848 by 848 pixels; color fundus image; modified Davis classification; camera: NIDEK AFC-230.
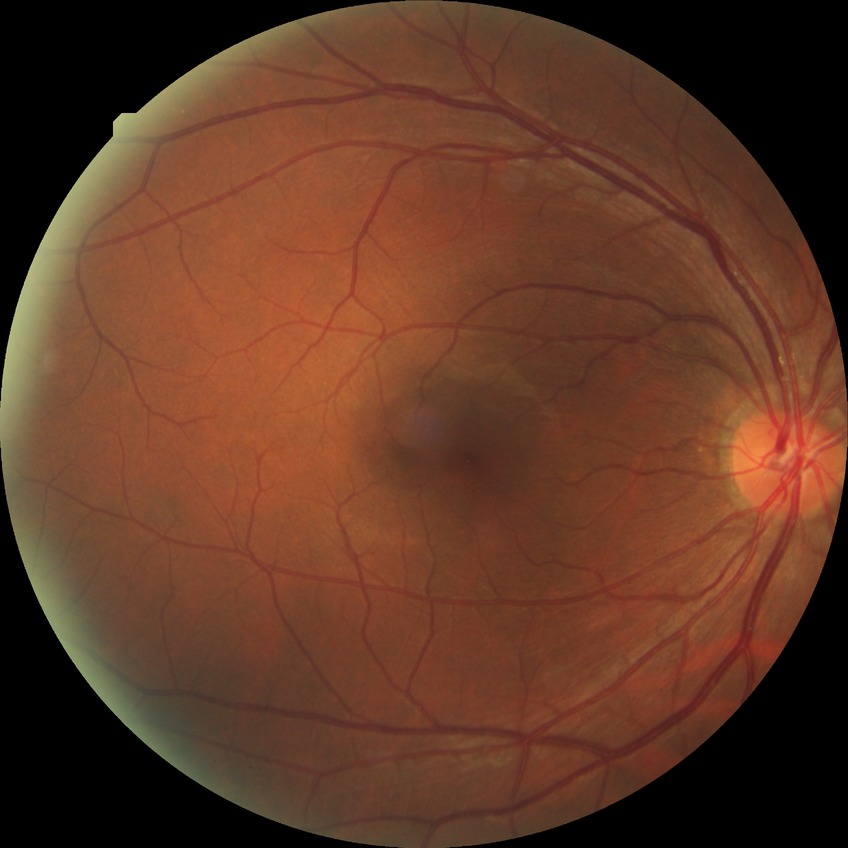 Diabetic retinopathy (DR): NDR (no diabetic retinopathy).